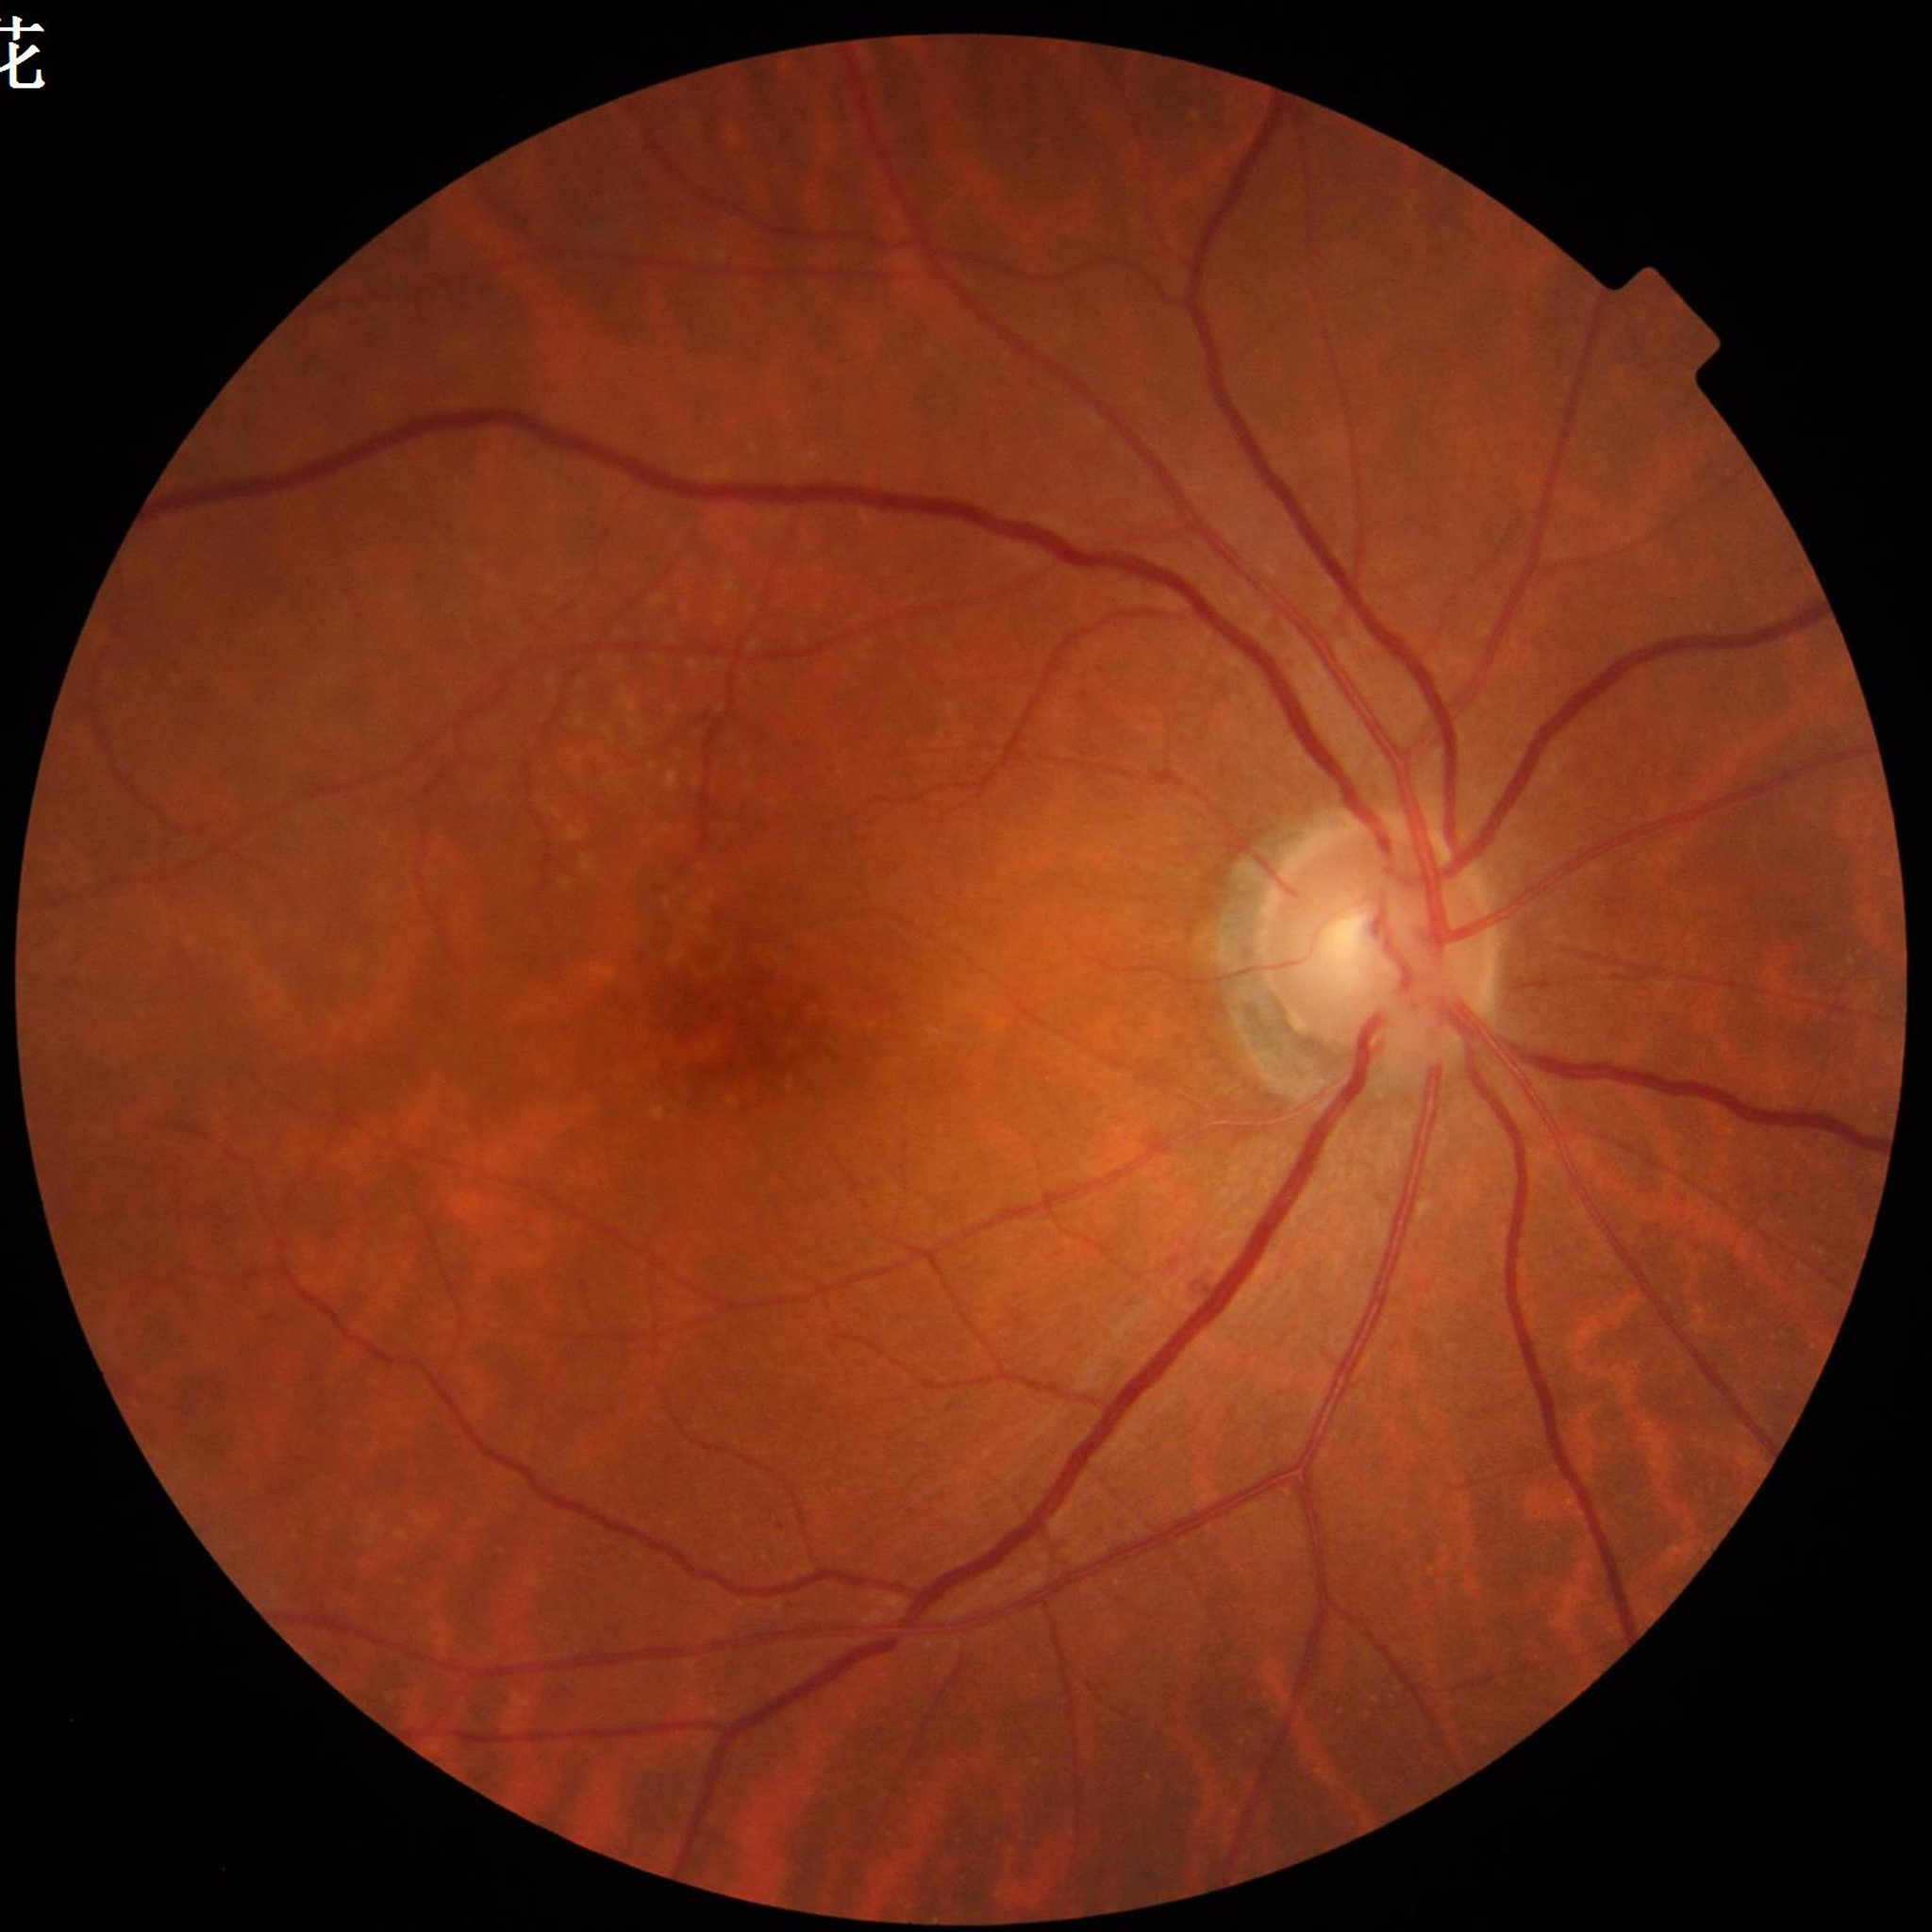

Diagnosed with diabetic retinopathy. Quality assessment: no quality issues identified.